FOV: 45 degrees.
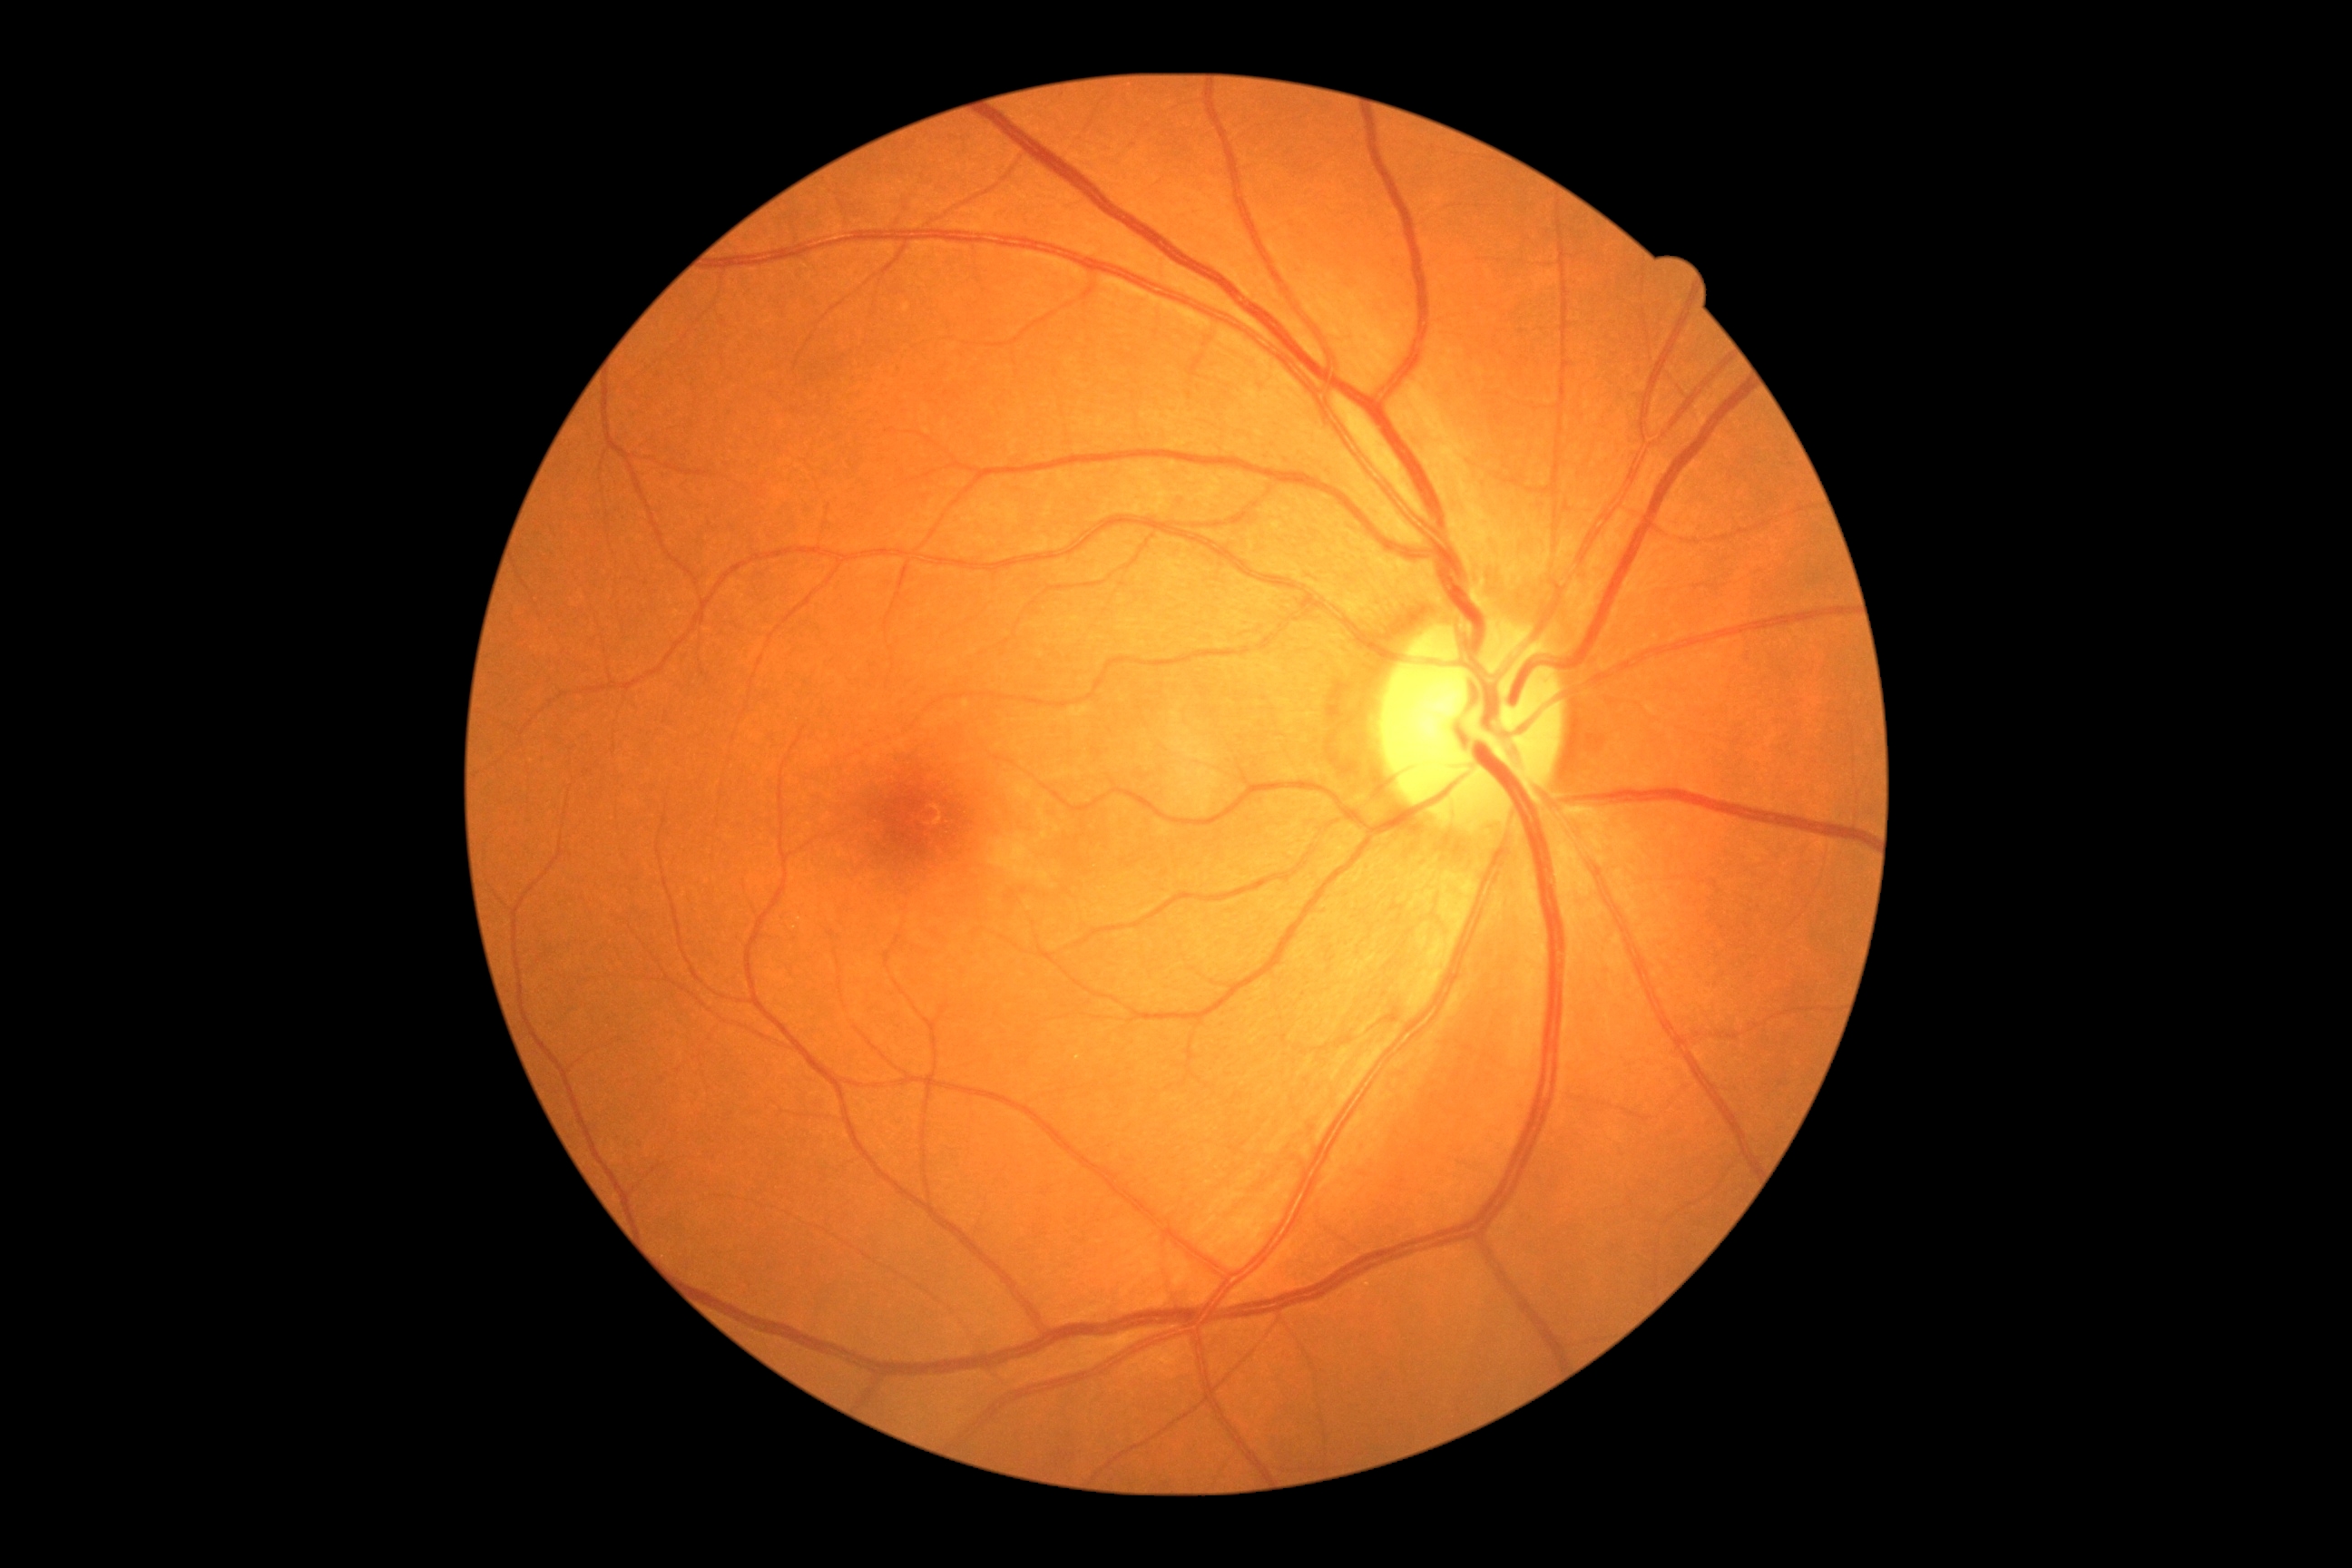 dr_grade: 0/4
dr_impression: no signs of DR